FOV: 45 degrees · CFP.
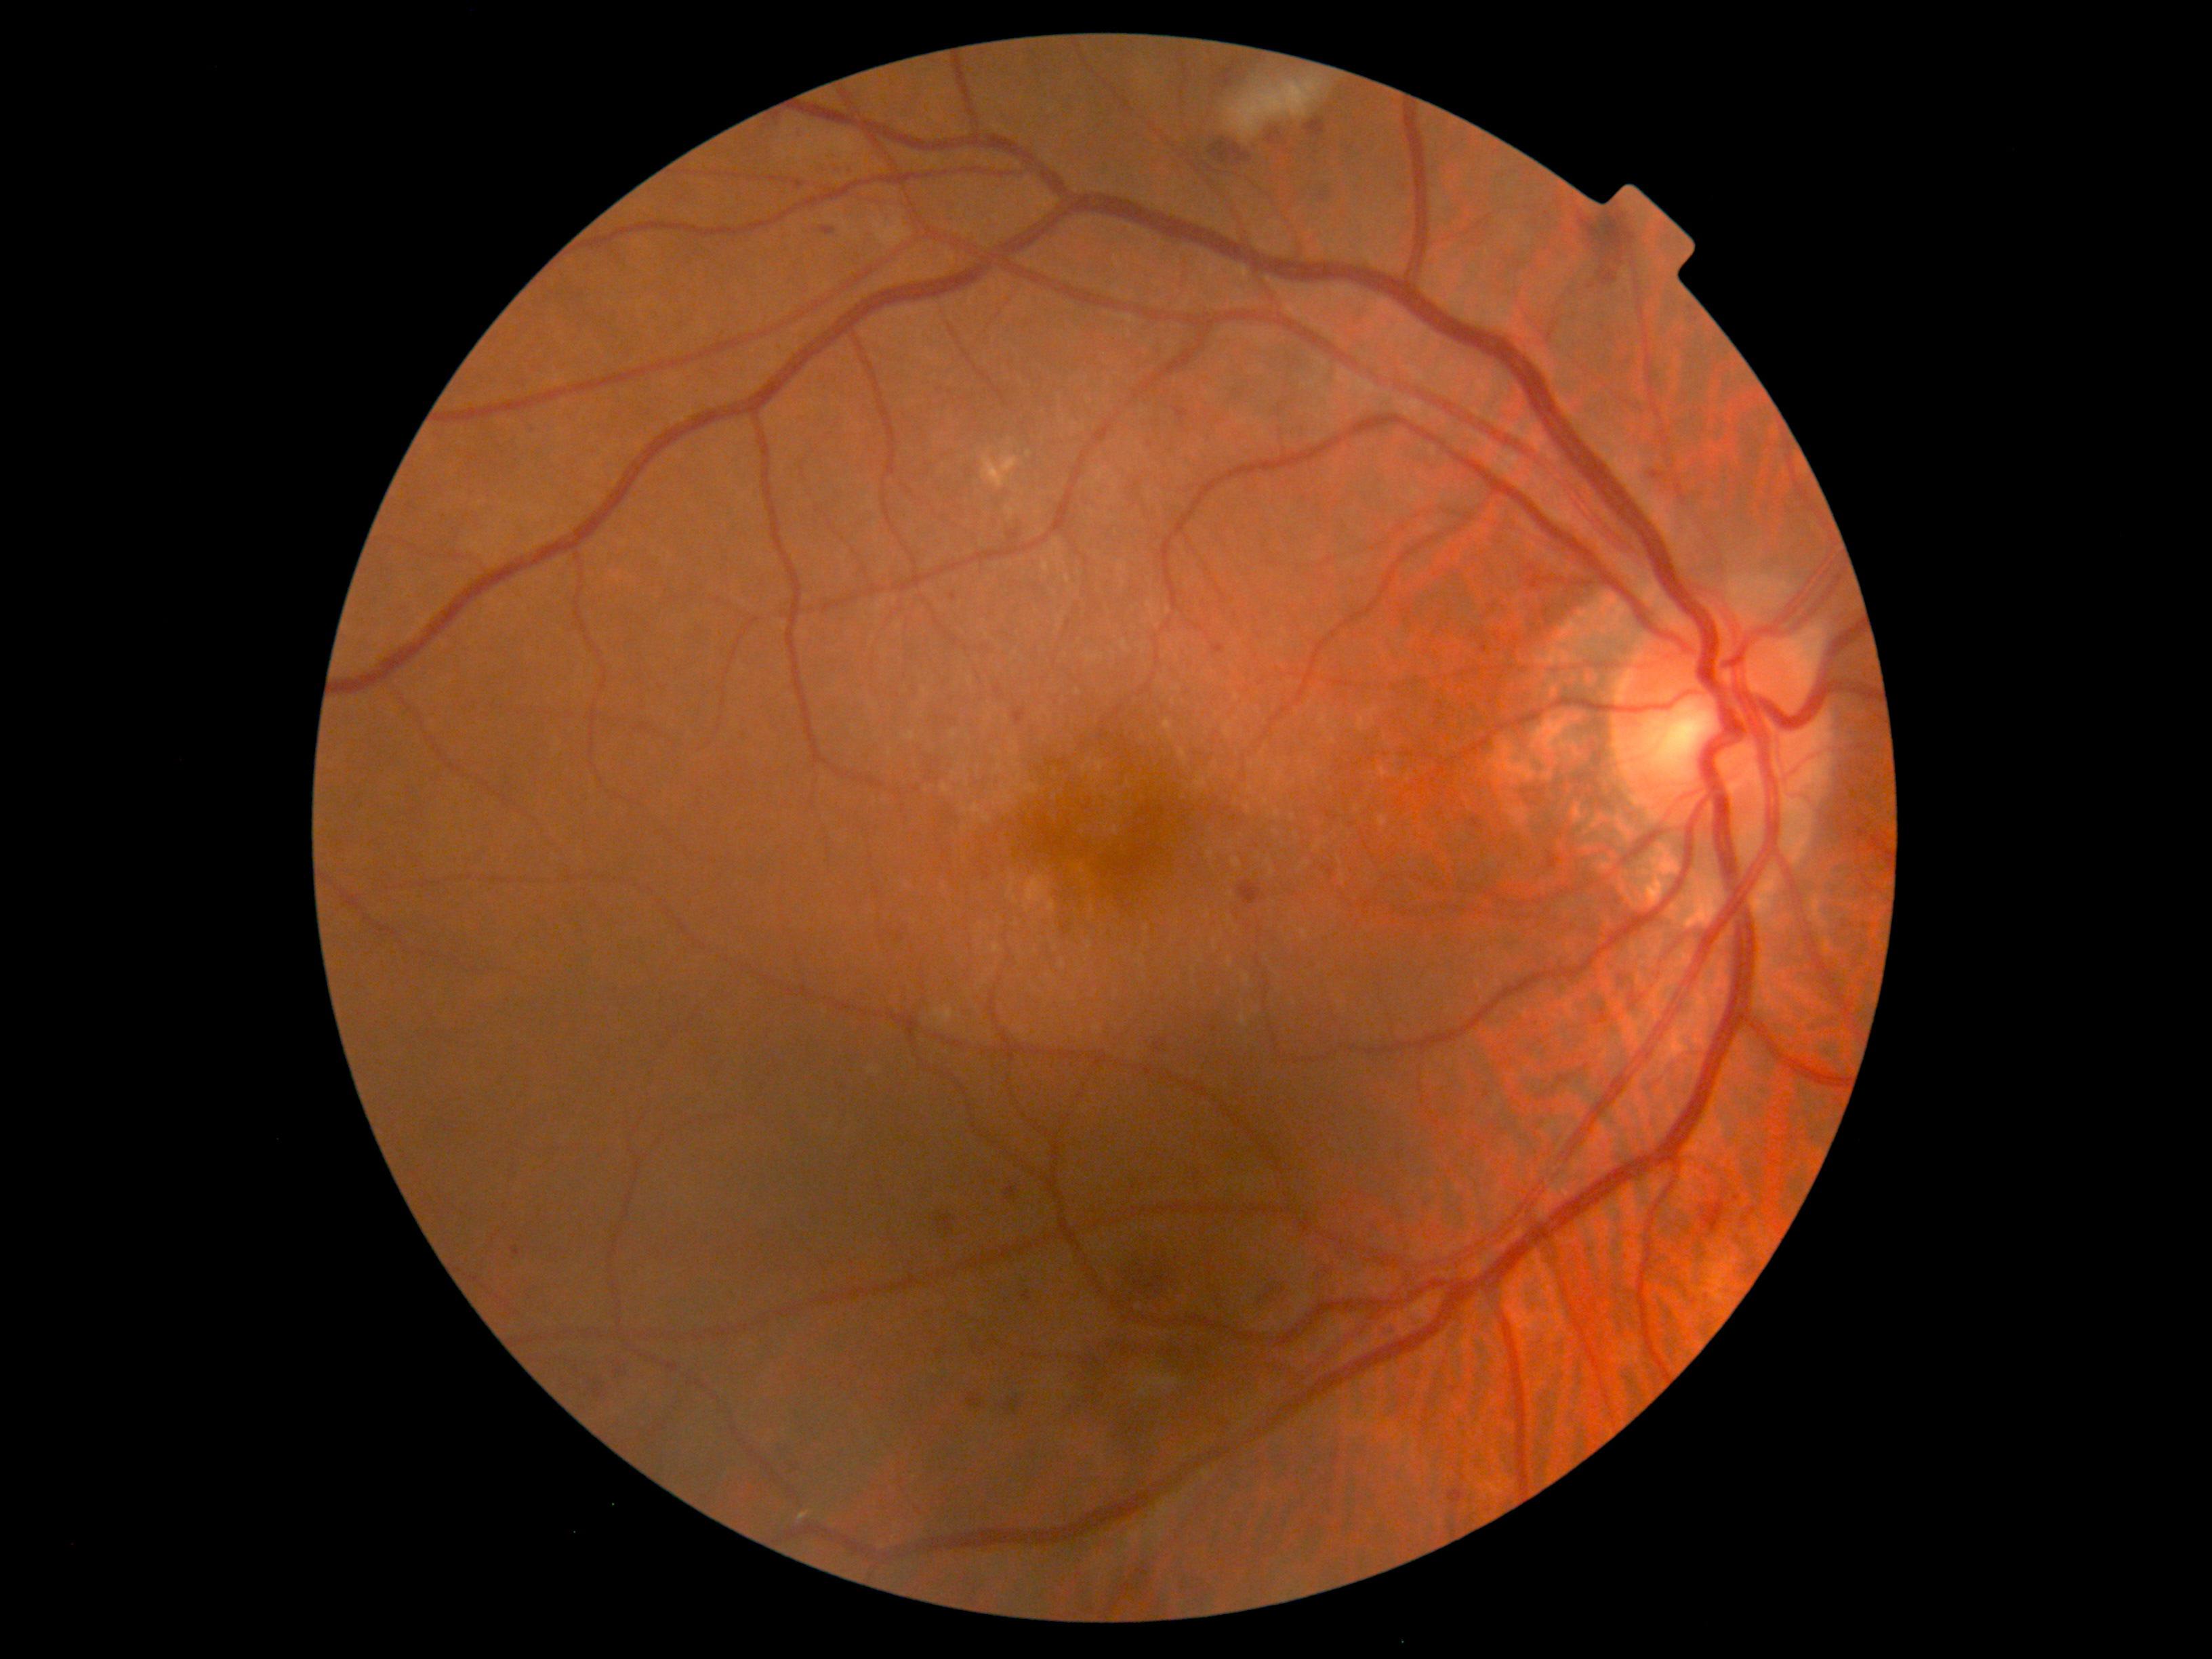
DR grade=moderate NPDR (2).